Phoenix ICON wide-field infant fundus image: 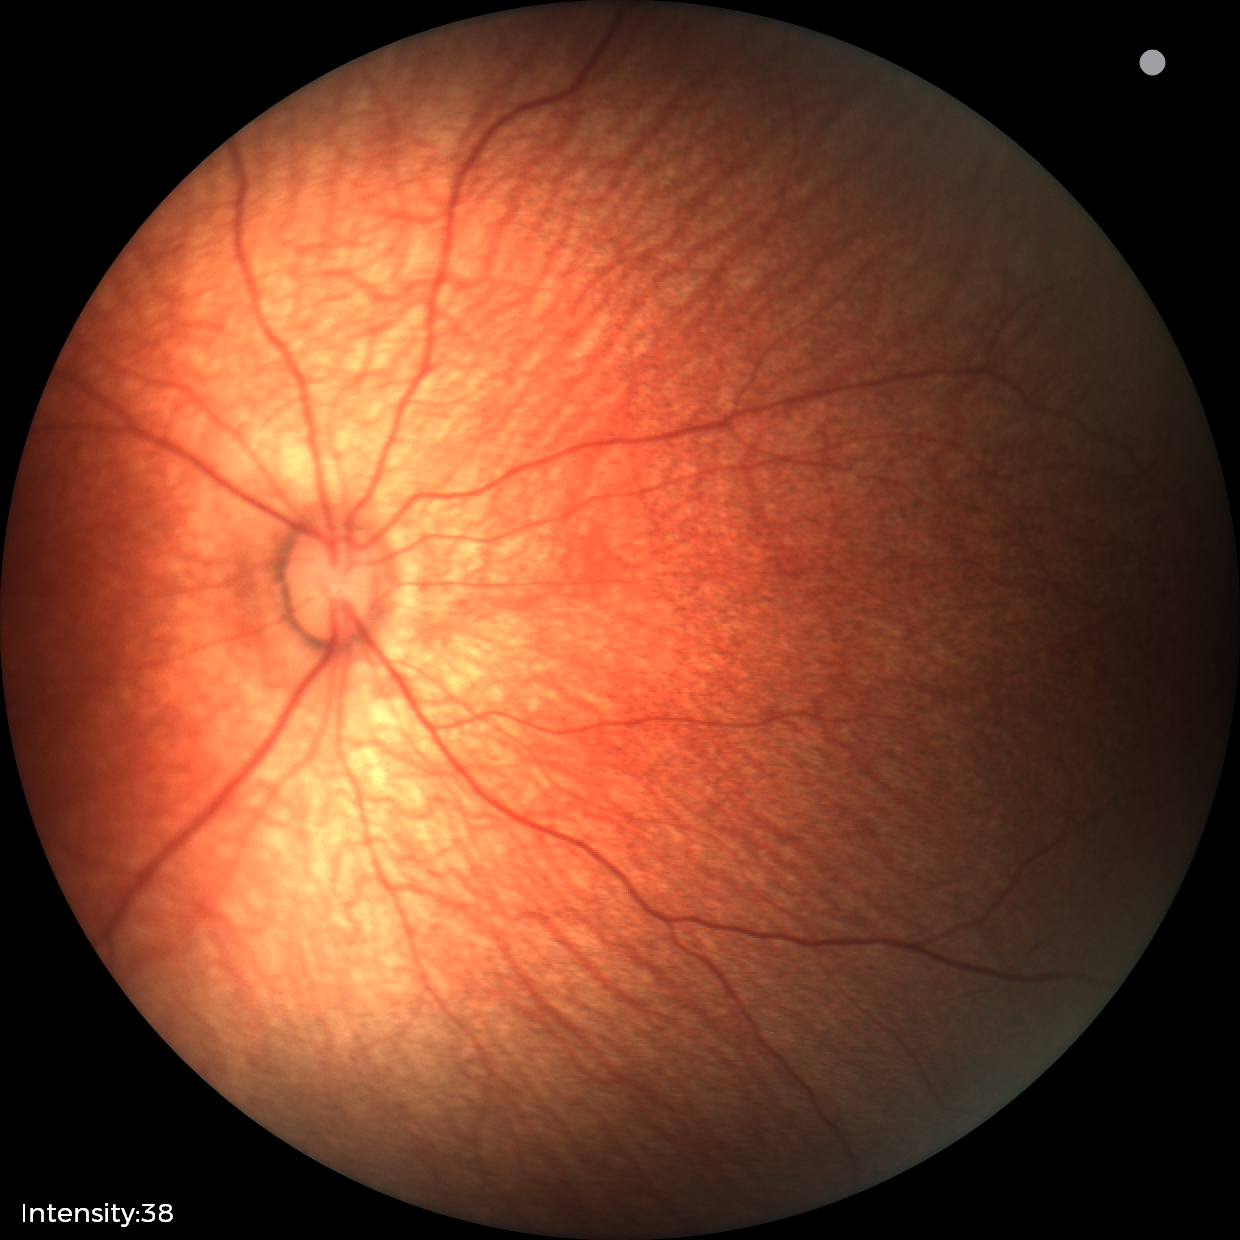 Examination with physiological retinal findings.